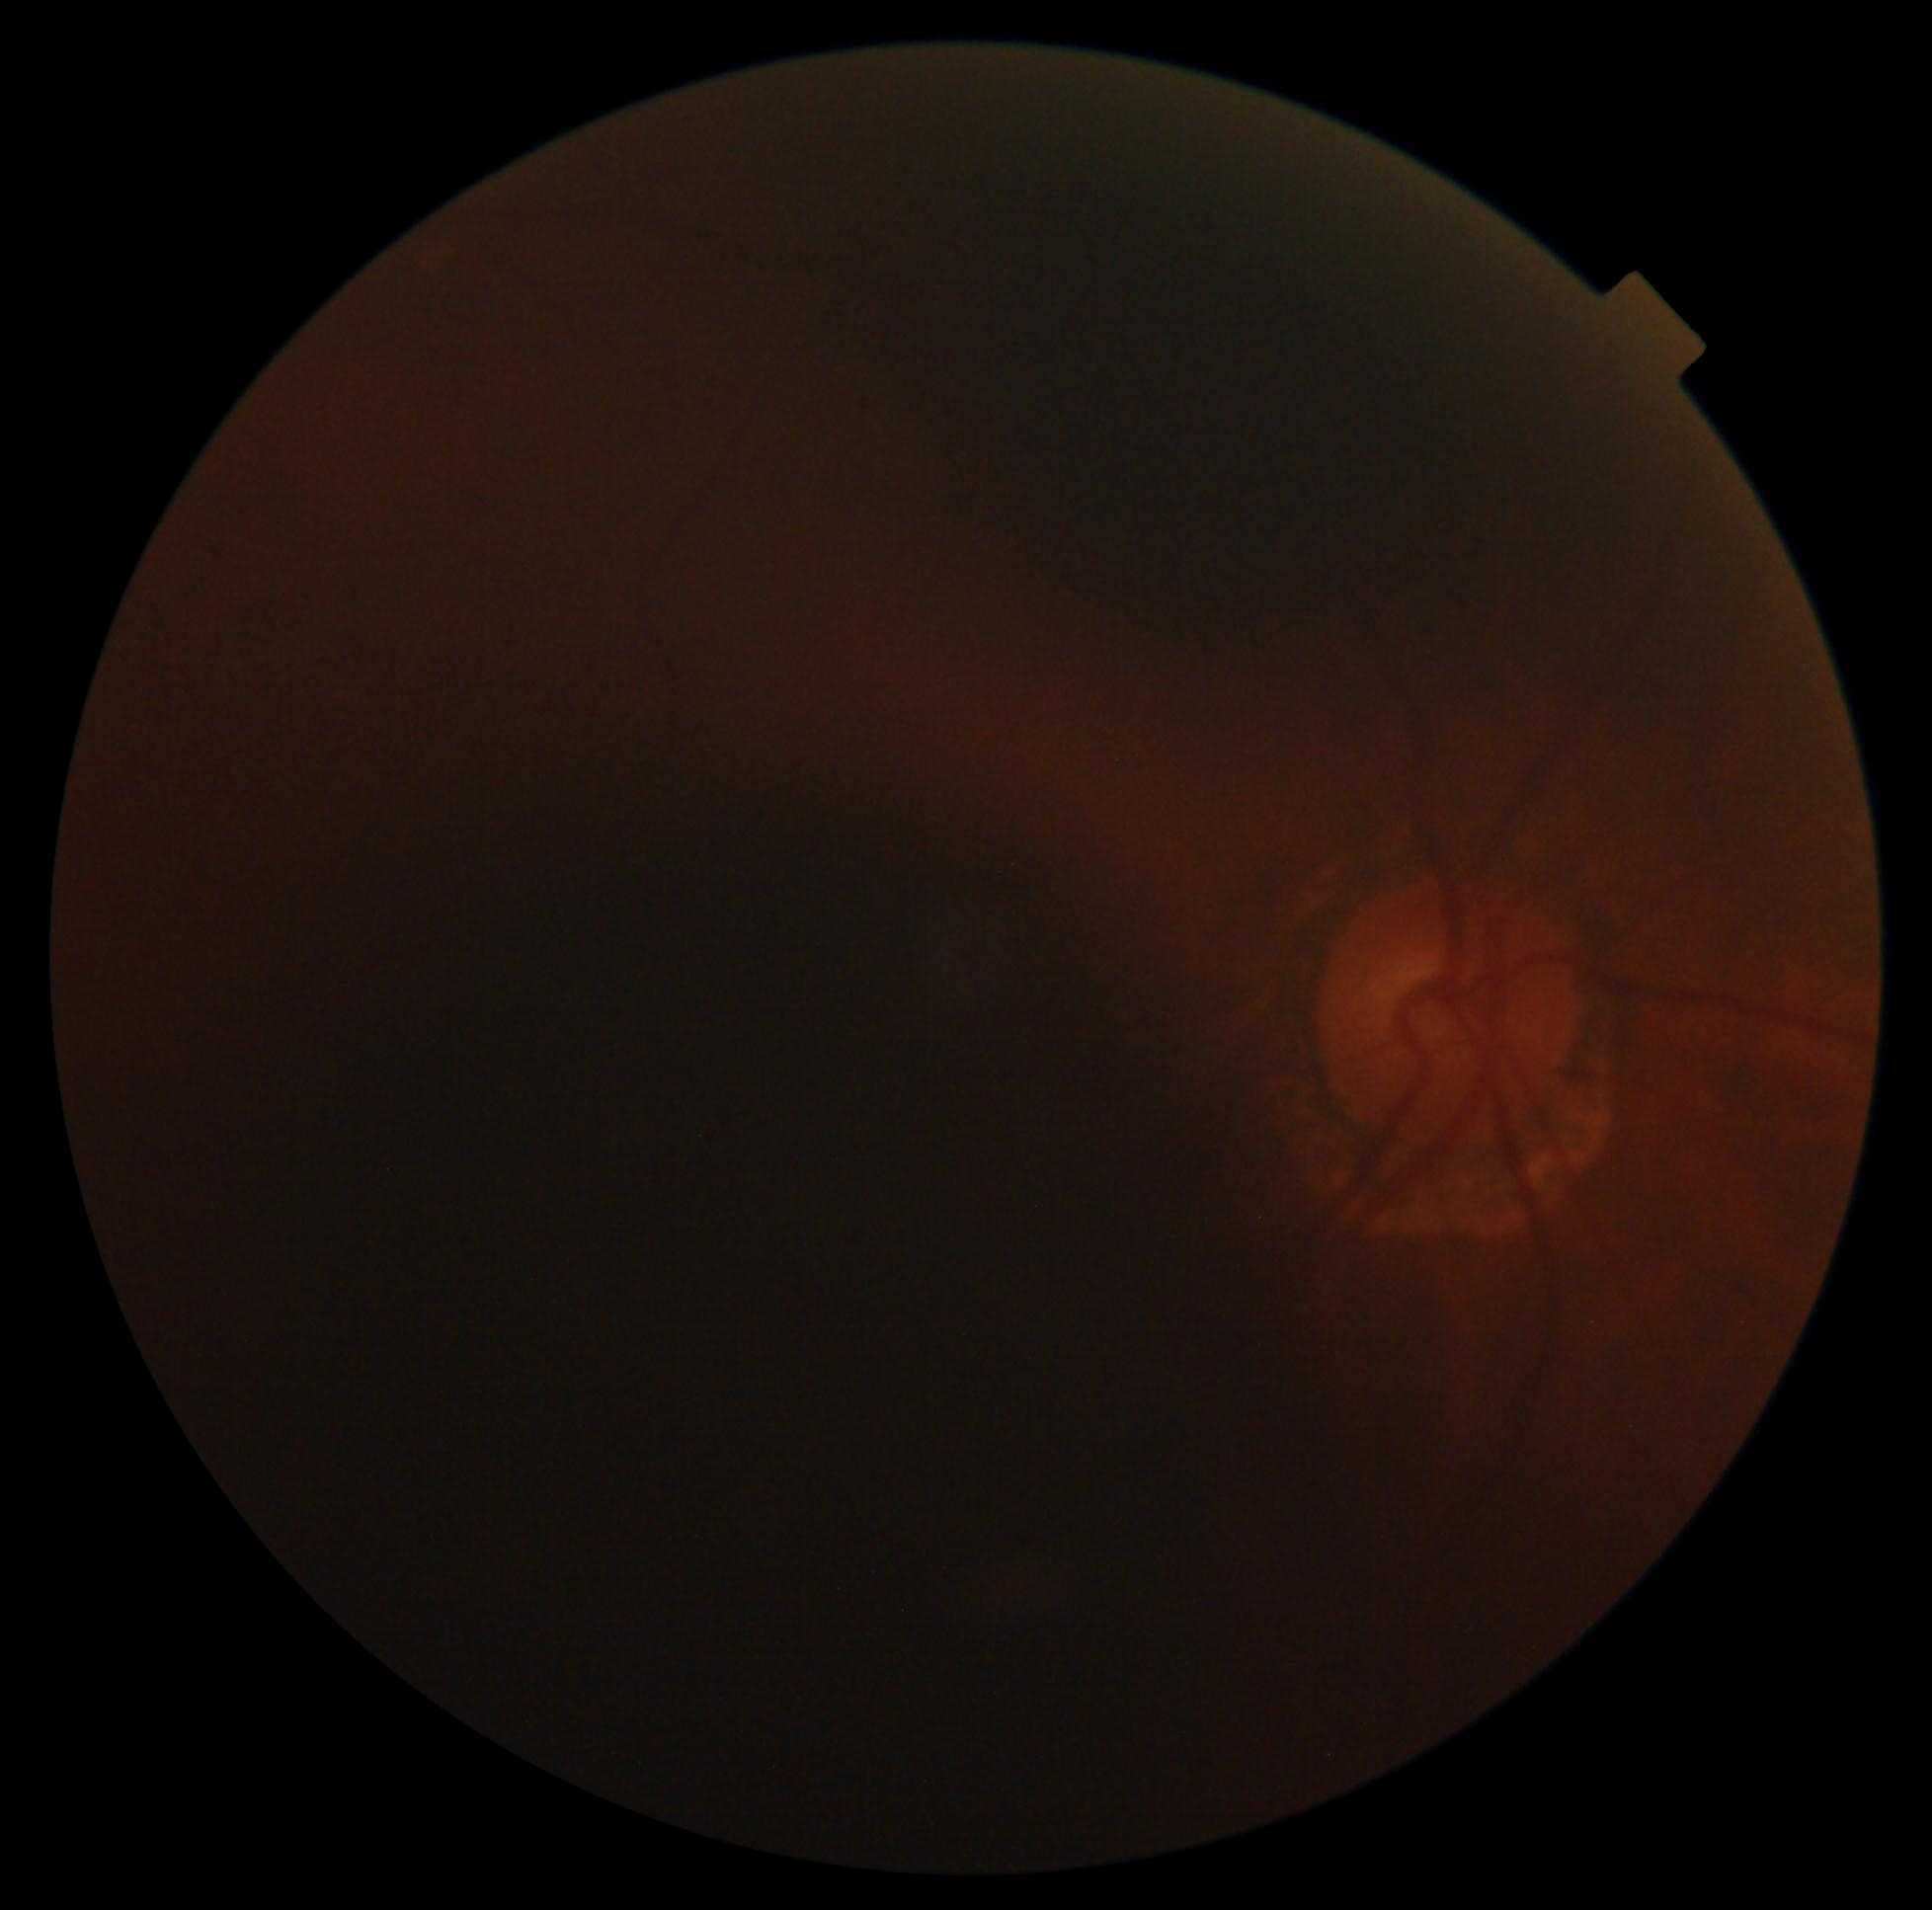 Diabetic retinopathy severity: ungradable.